1659x2212px — 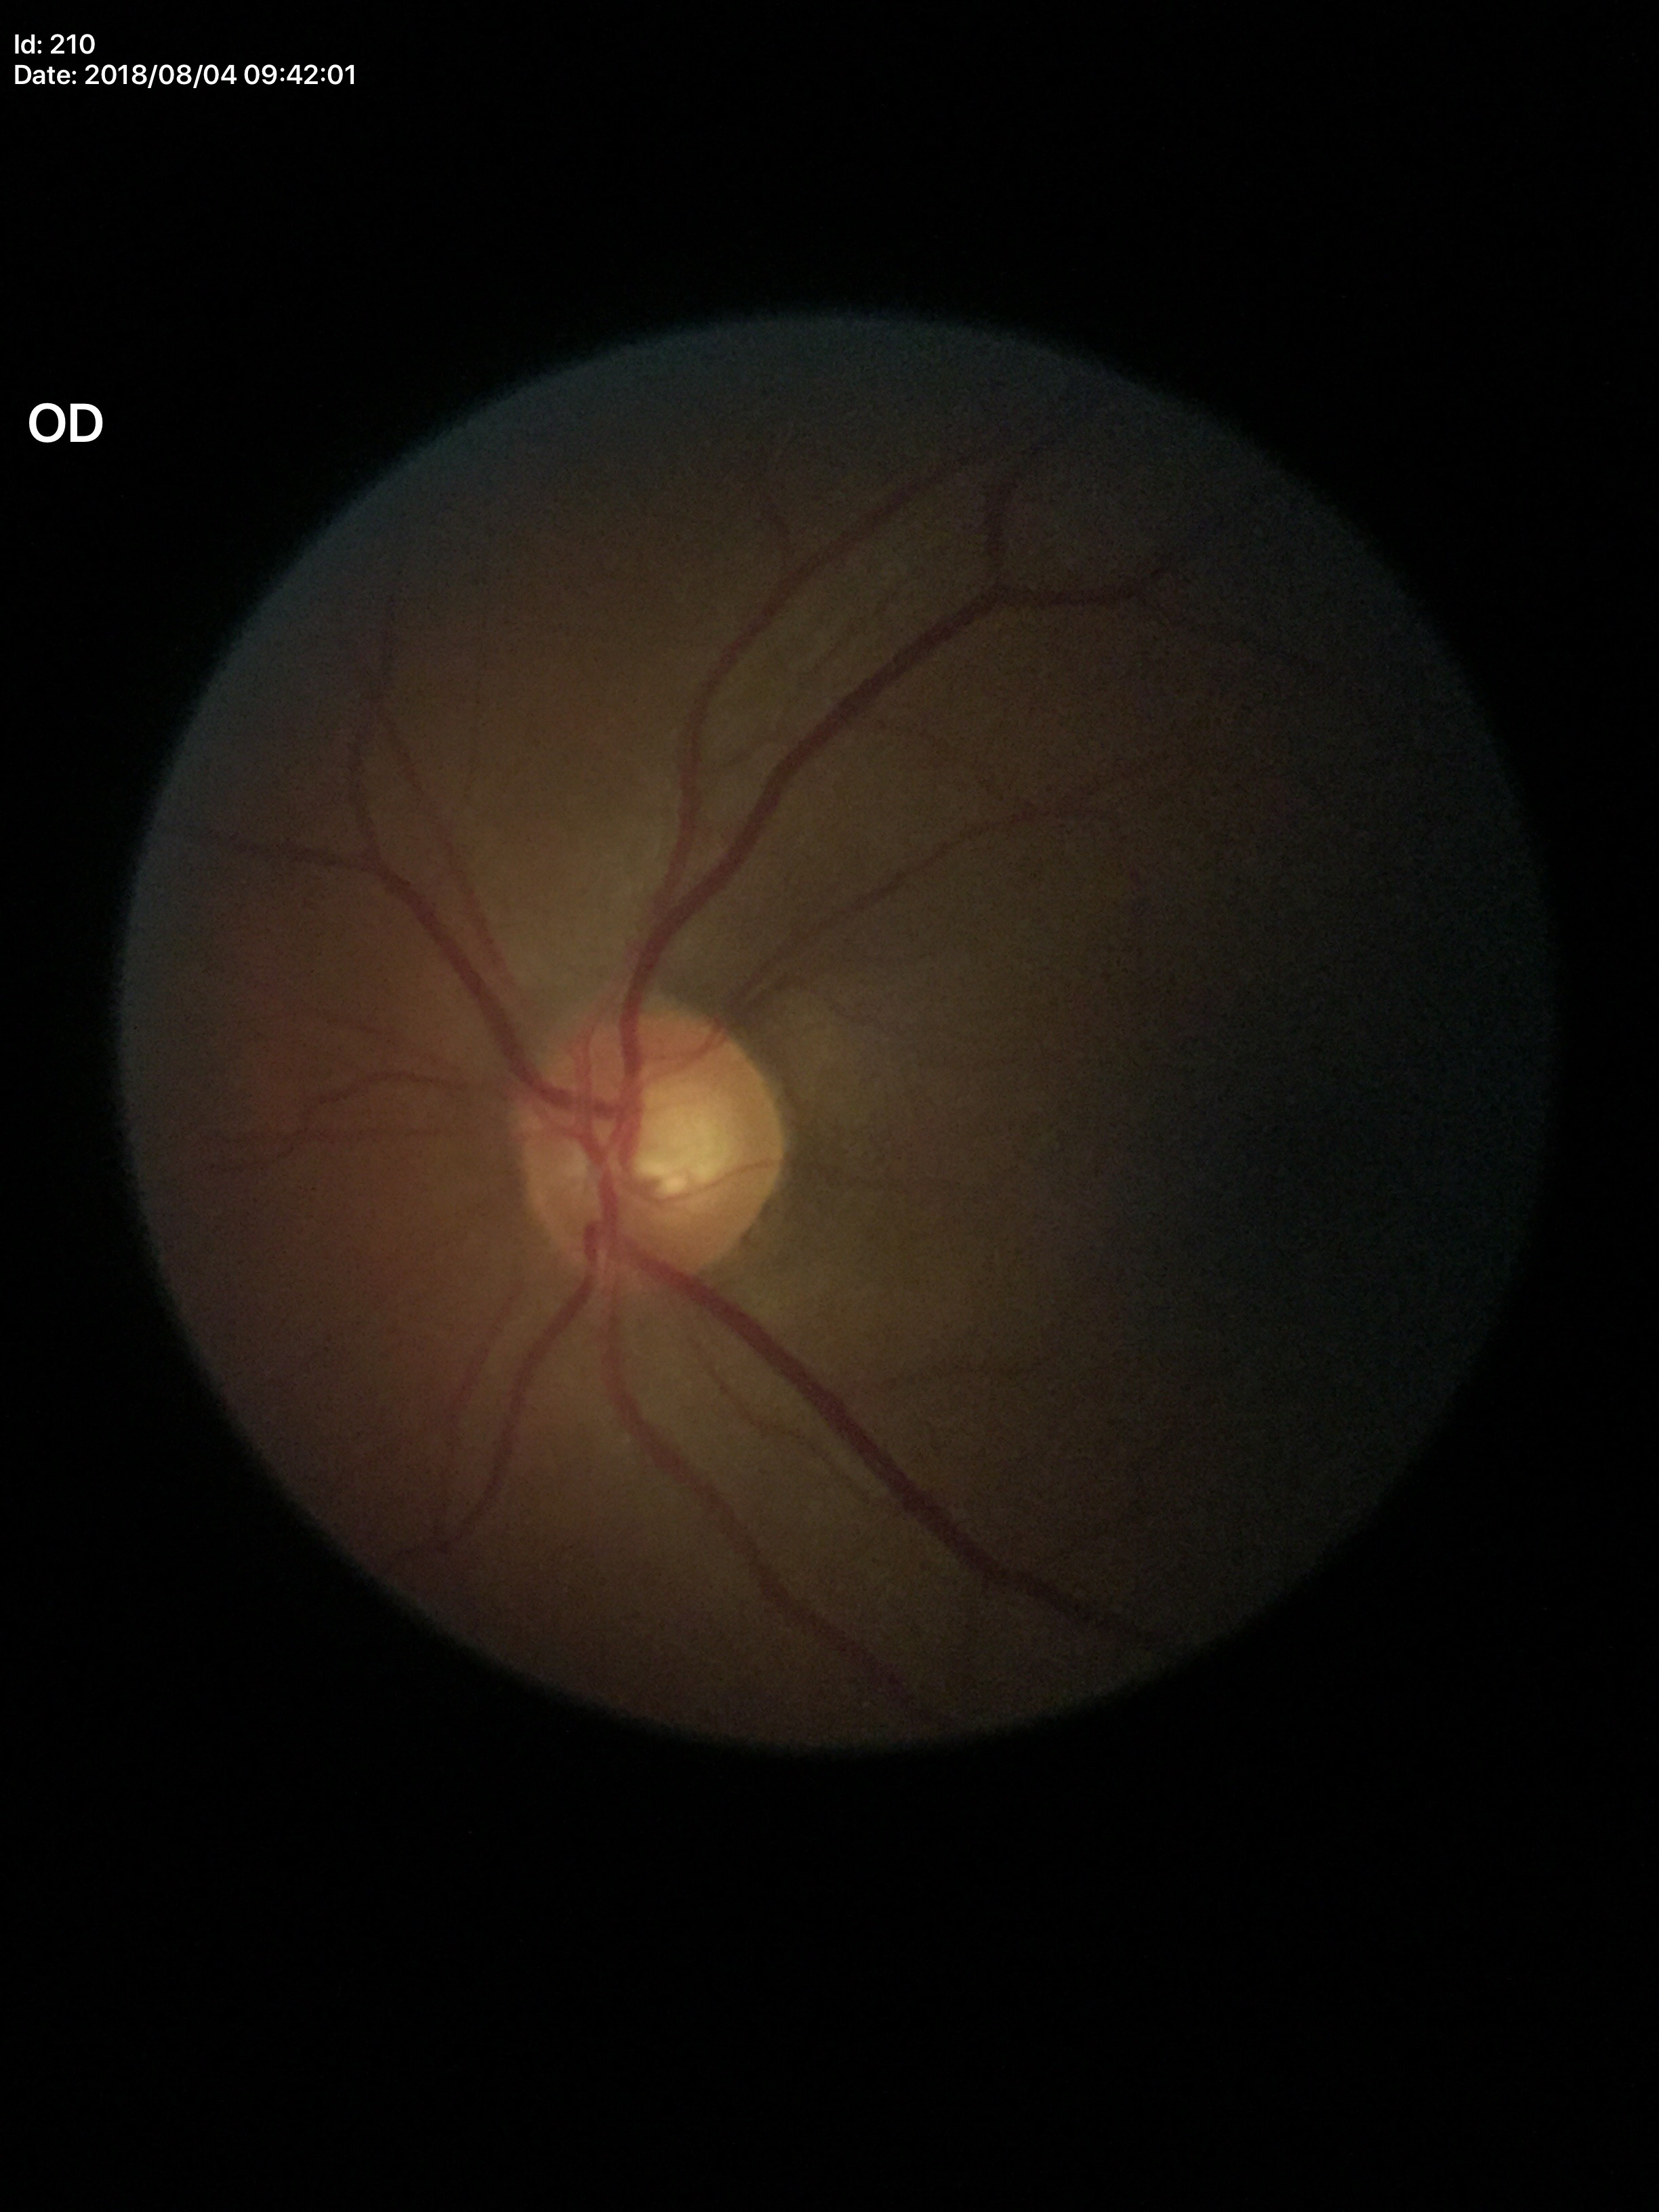 Glaucoma screening impression: no suspicious findings.
VCDR of 0.56.